Color fundus image, 2102 by 1736 pixels.
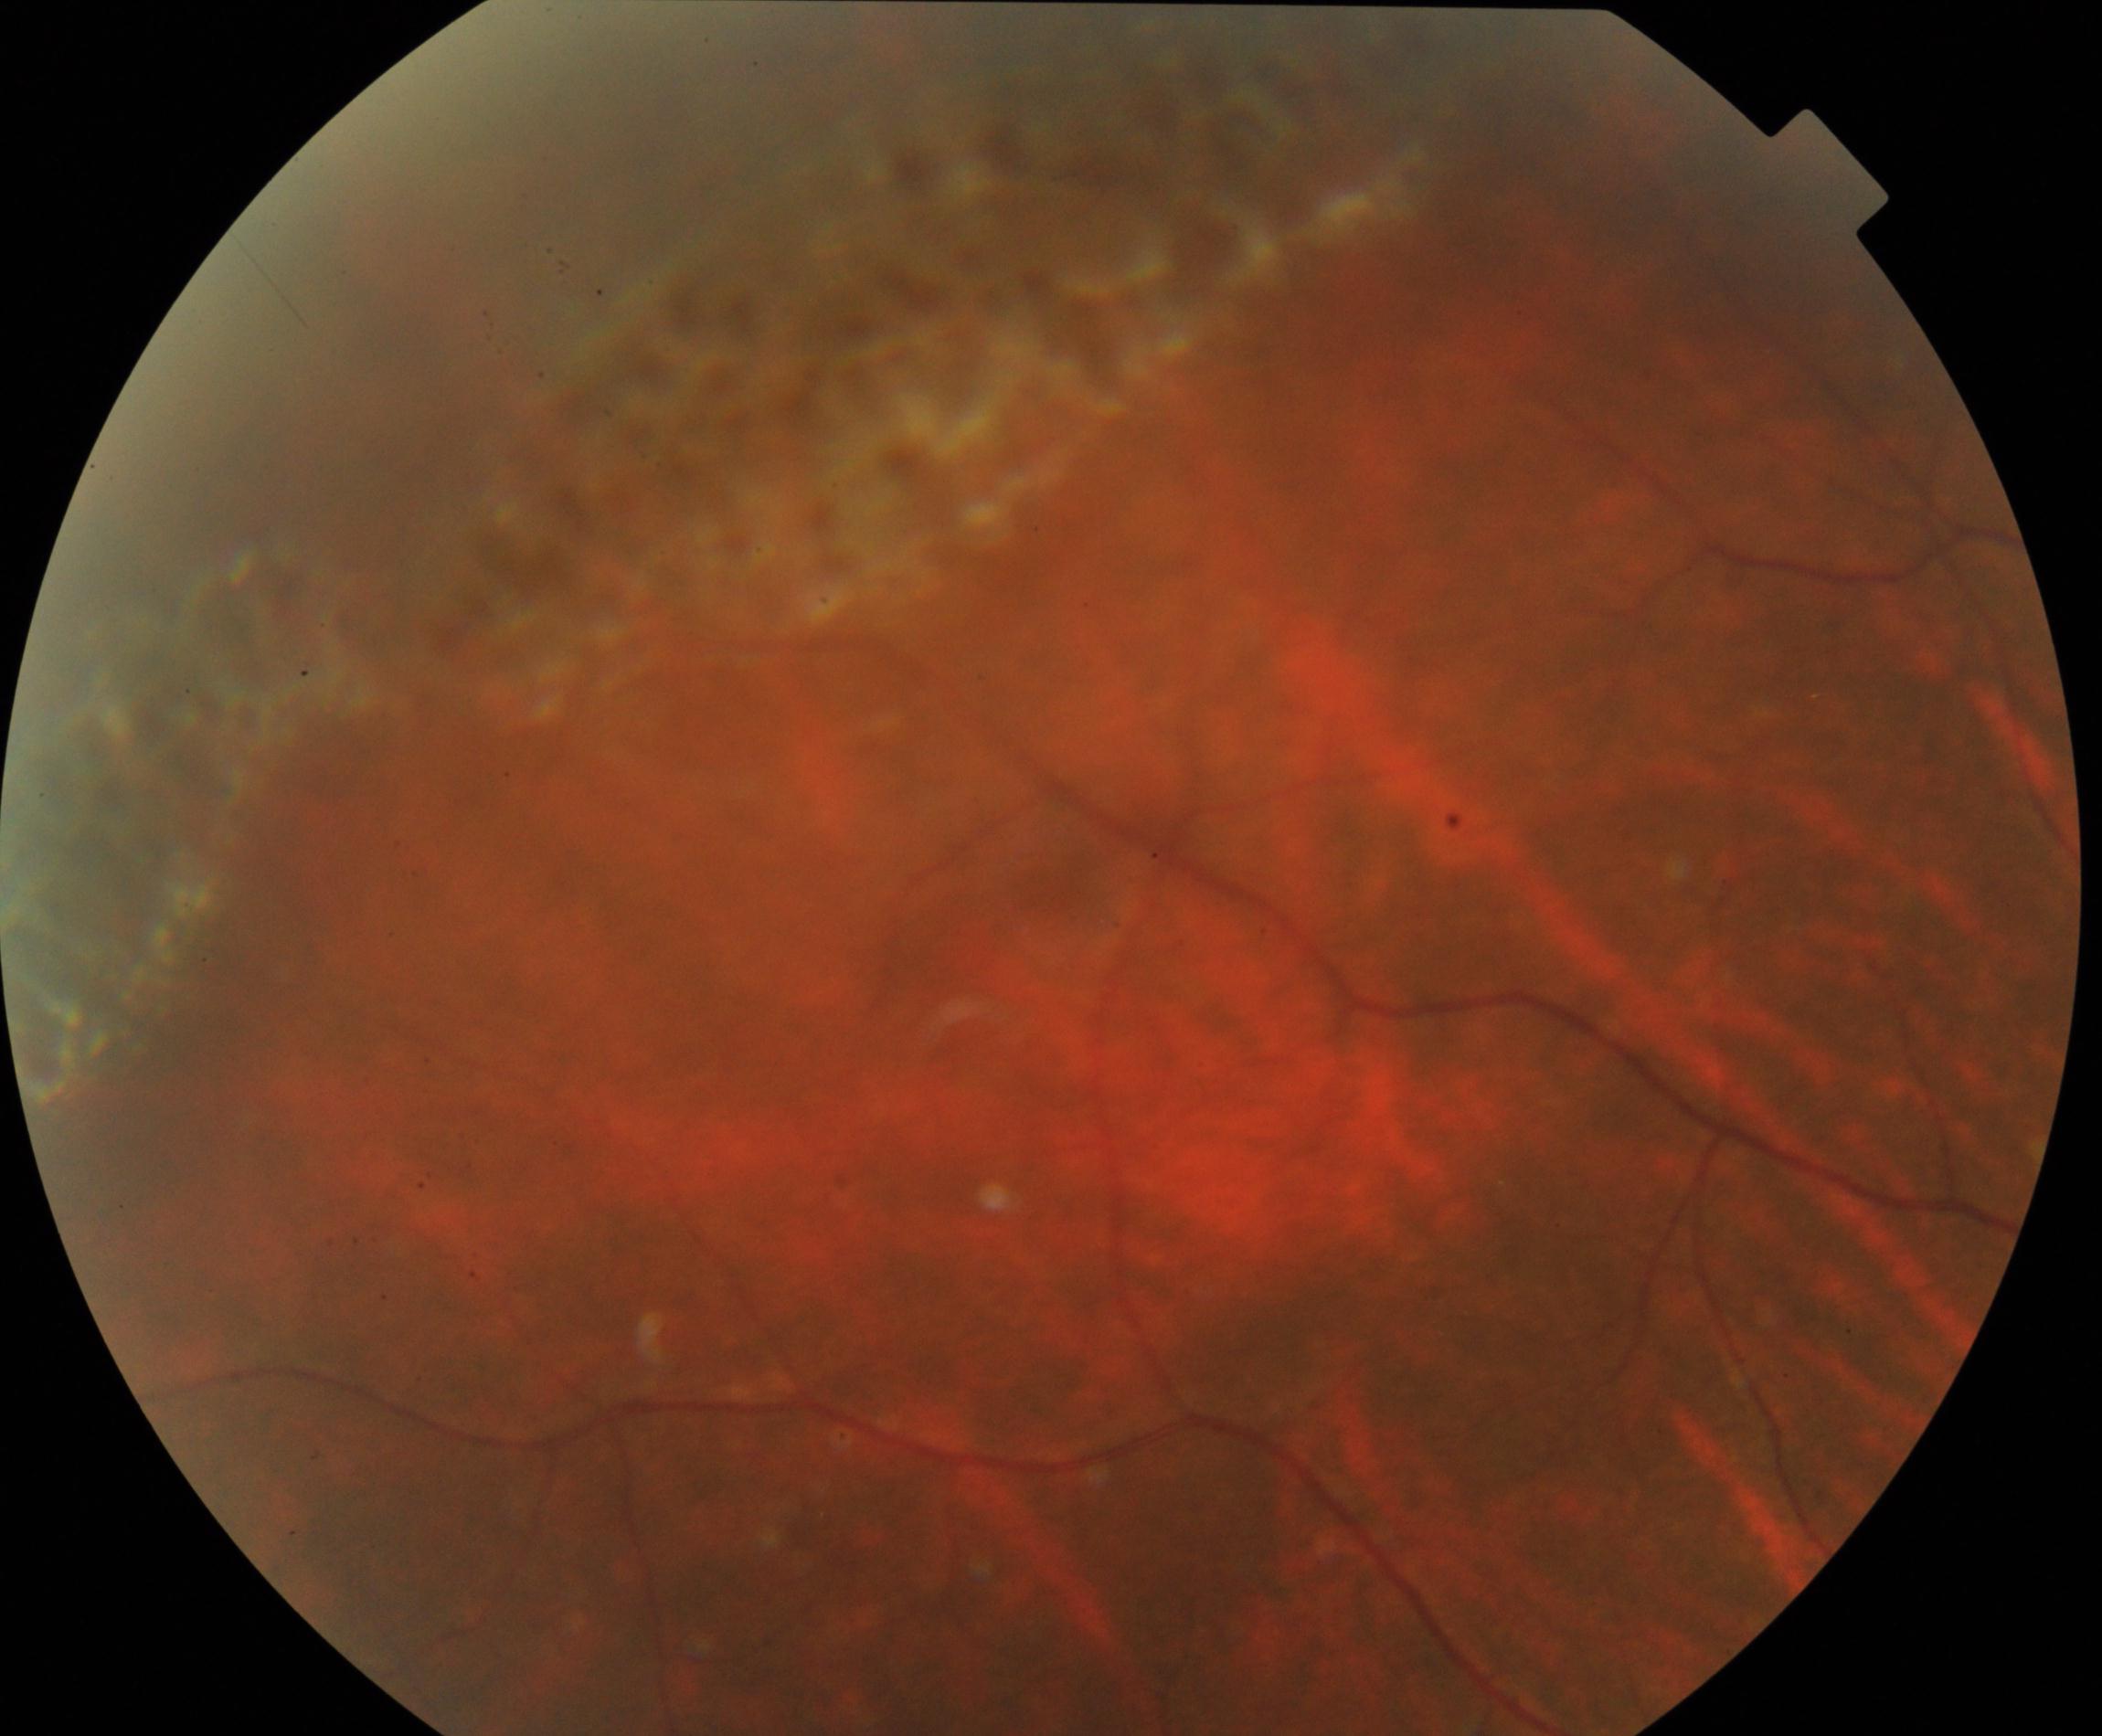 Findings: peripheral retinal degeneration and break.